Fundus photo taken with a portable handheld camera: 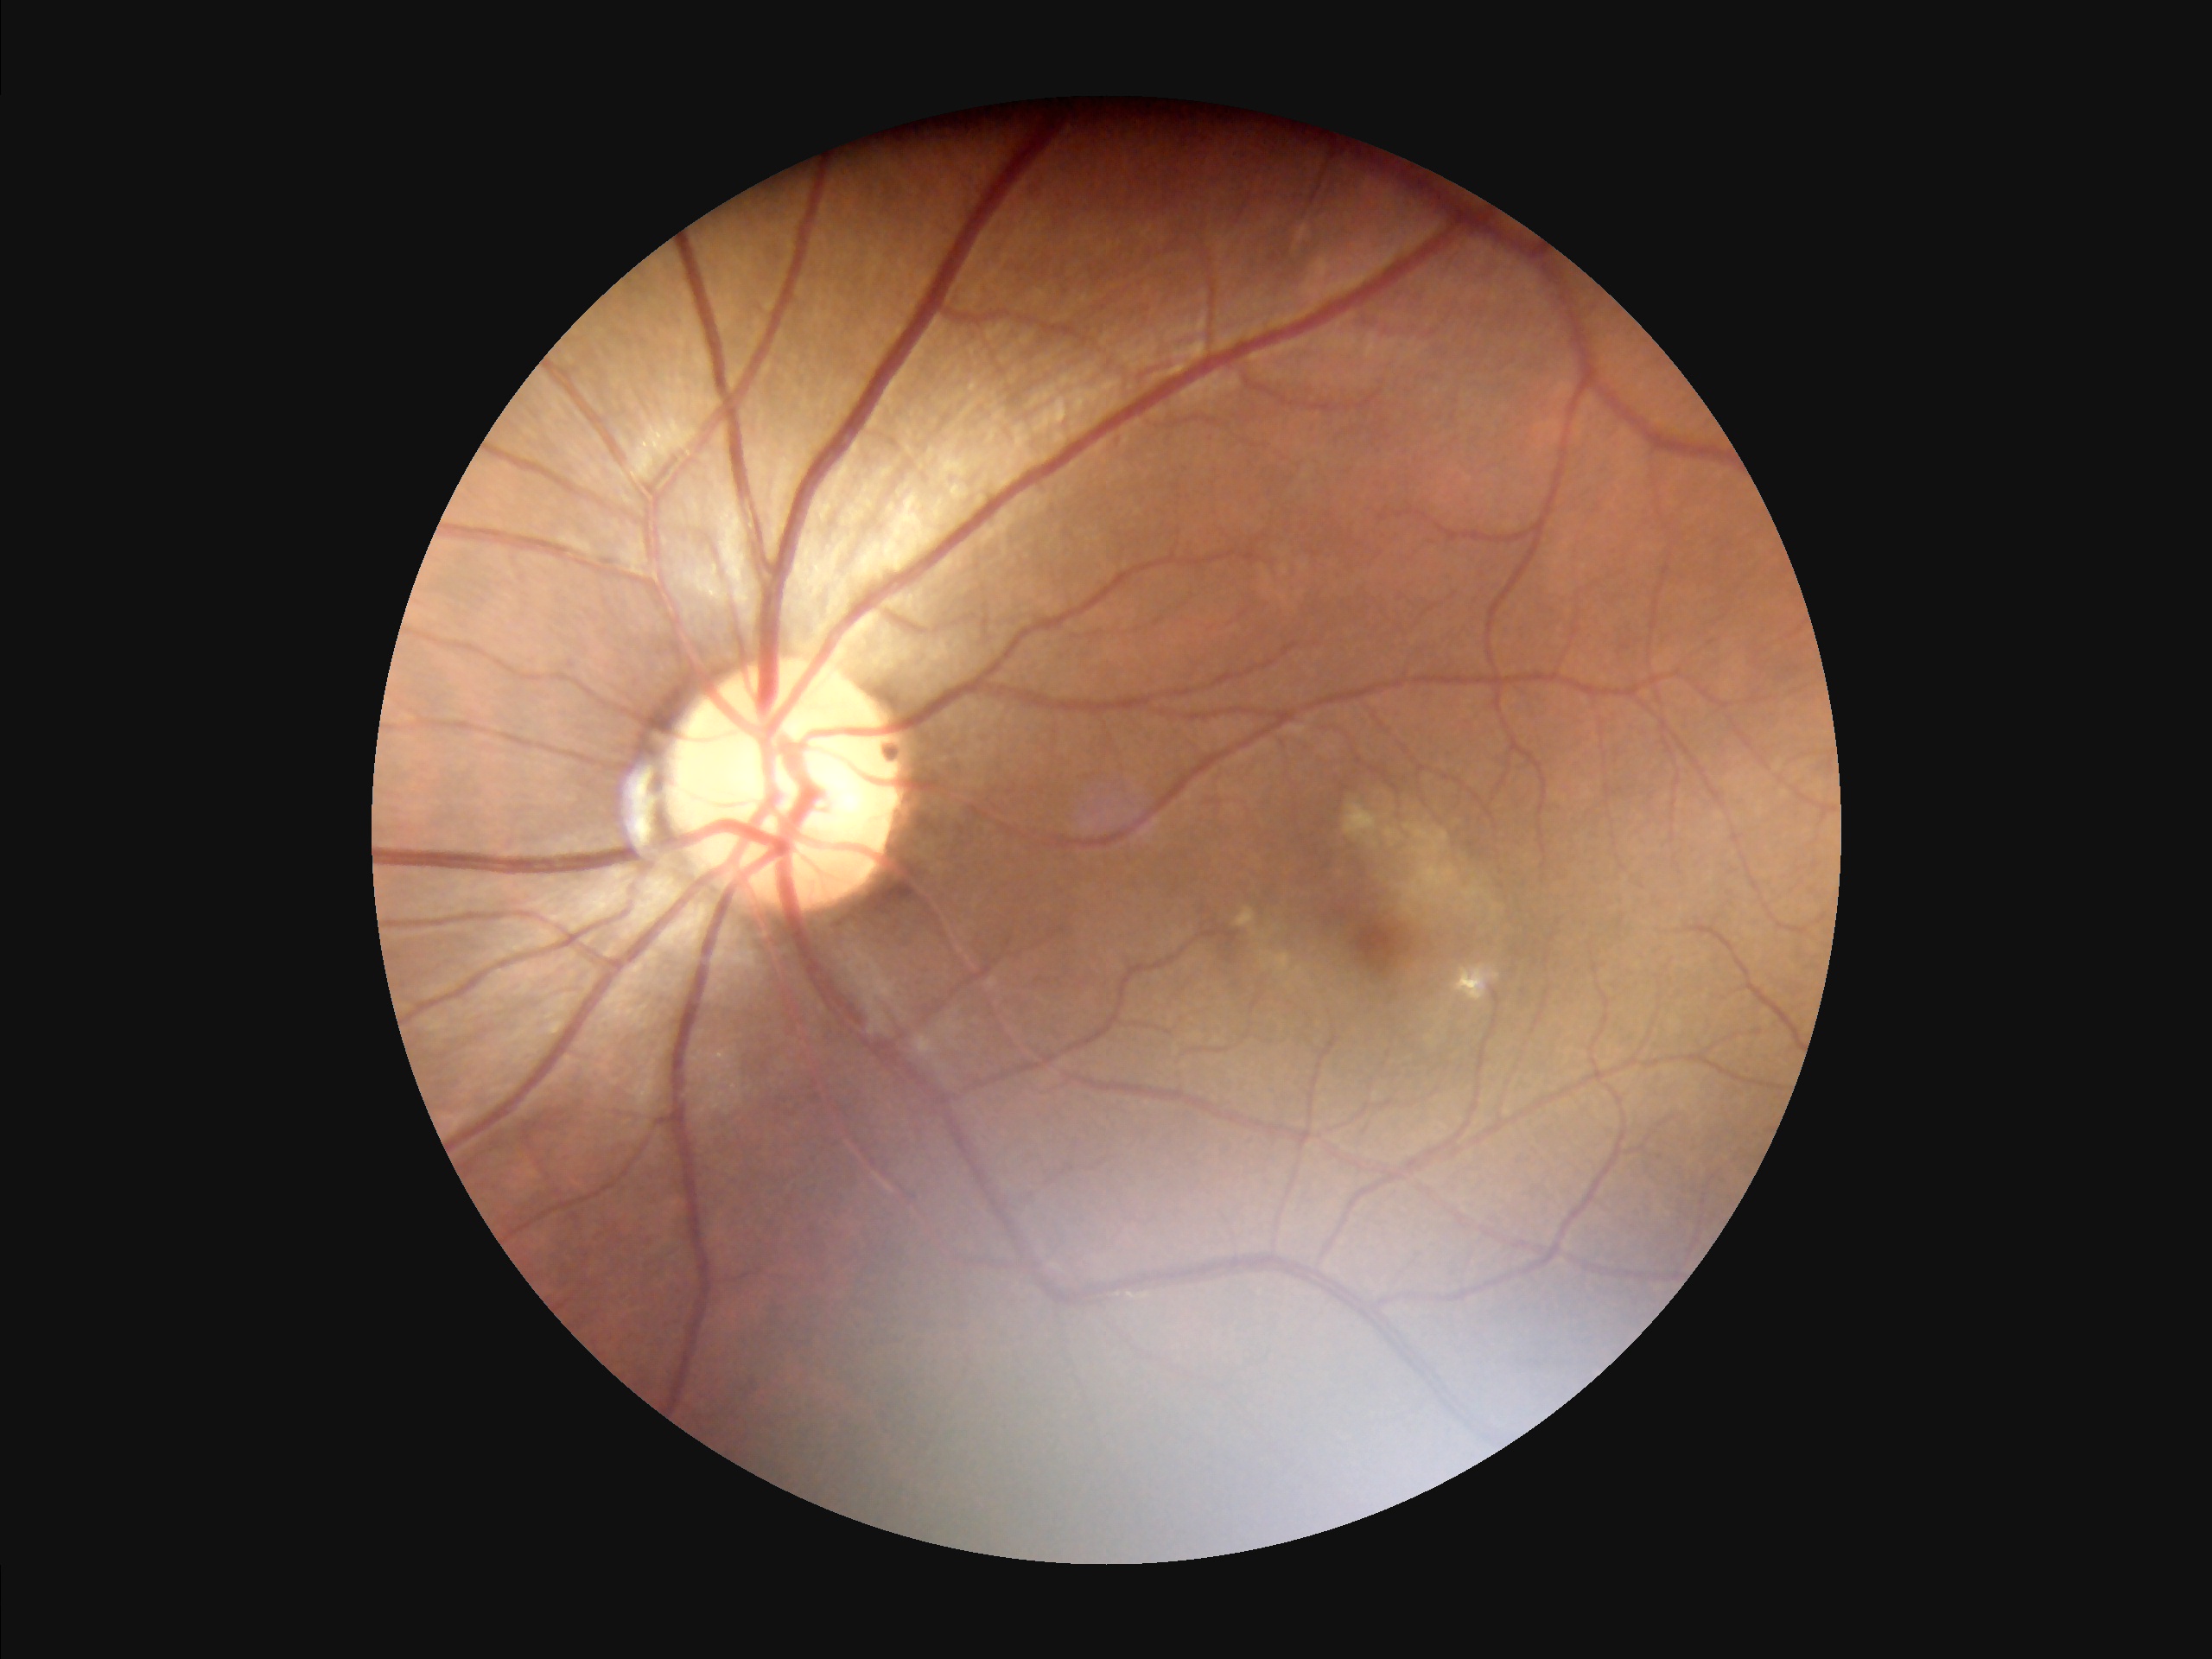
Image quality assessment: illumination/color: uneven | overall: satisfactory | contrast: good | clarity: clear.